FOV: 30 degrees · intraocular pressure (IOP) by non-contact tonometry: 18 mmHg · image size 2212x1661 · corneal thickness: 525 µm · refraction: sphere +0.75 D, cylinder -0.5 D, axis 80° · 57 years old · female patient
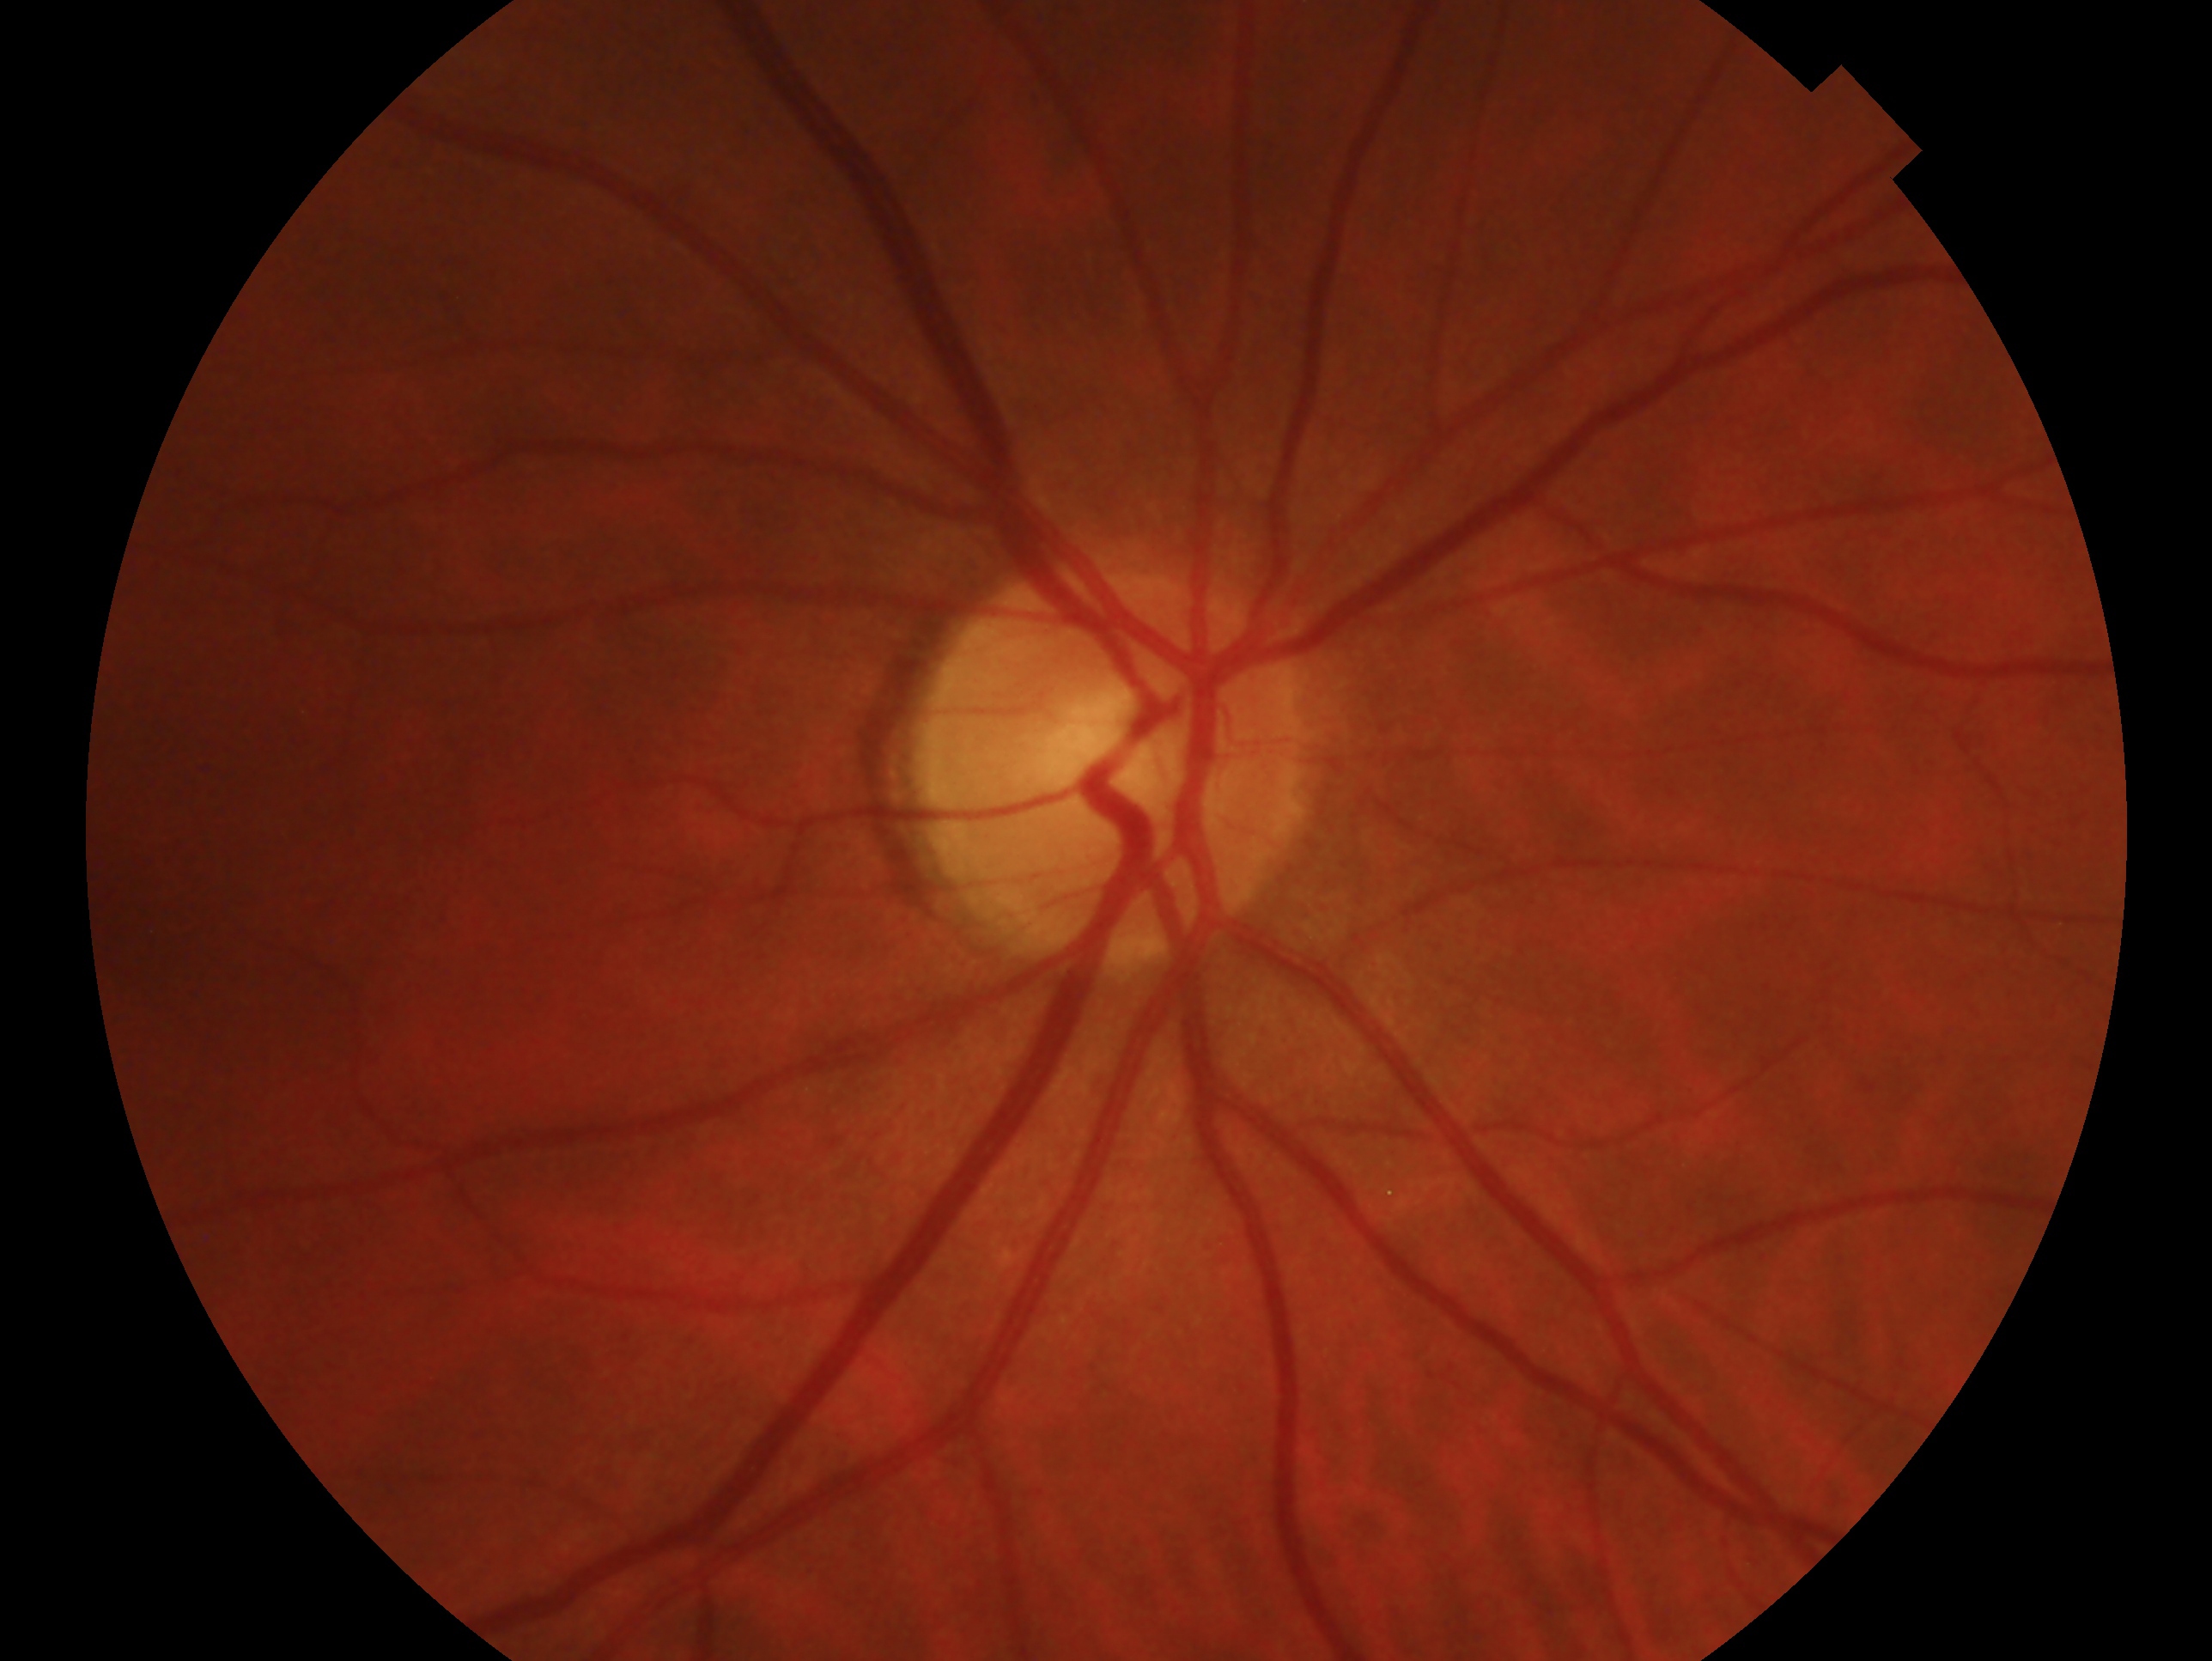
Imaged eye: right. Clinical classification — no evidence of glaucoma.